Davis DR grading · posterior pole photograph — 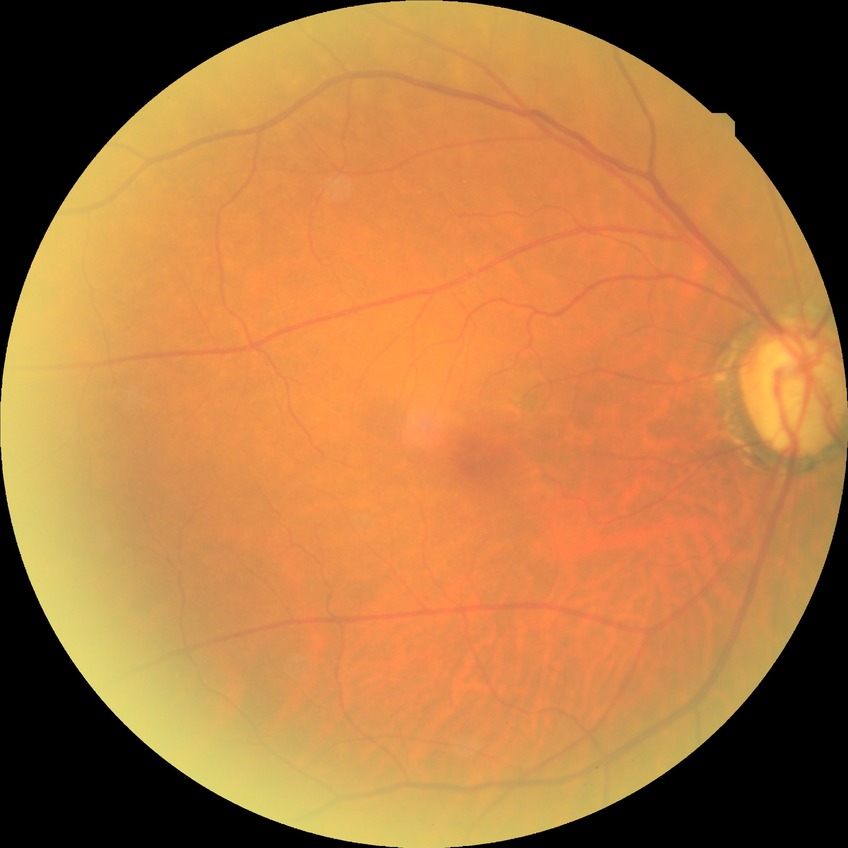
davis_grade: NDR (no diabetic retinopathy)